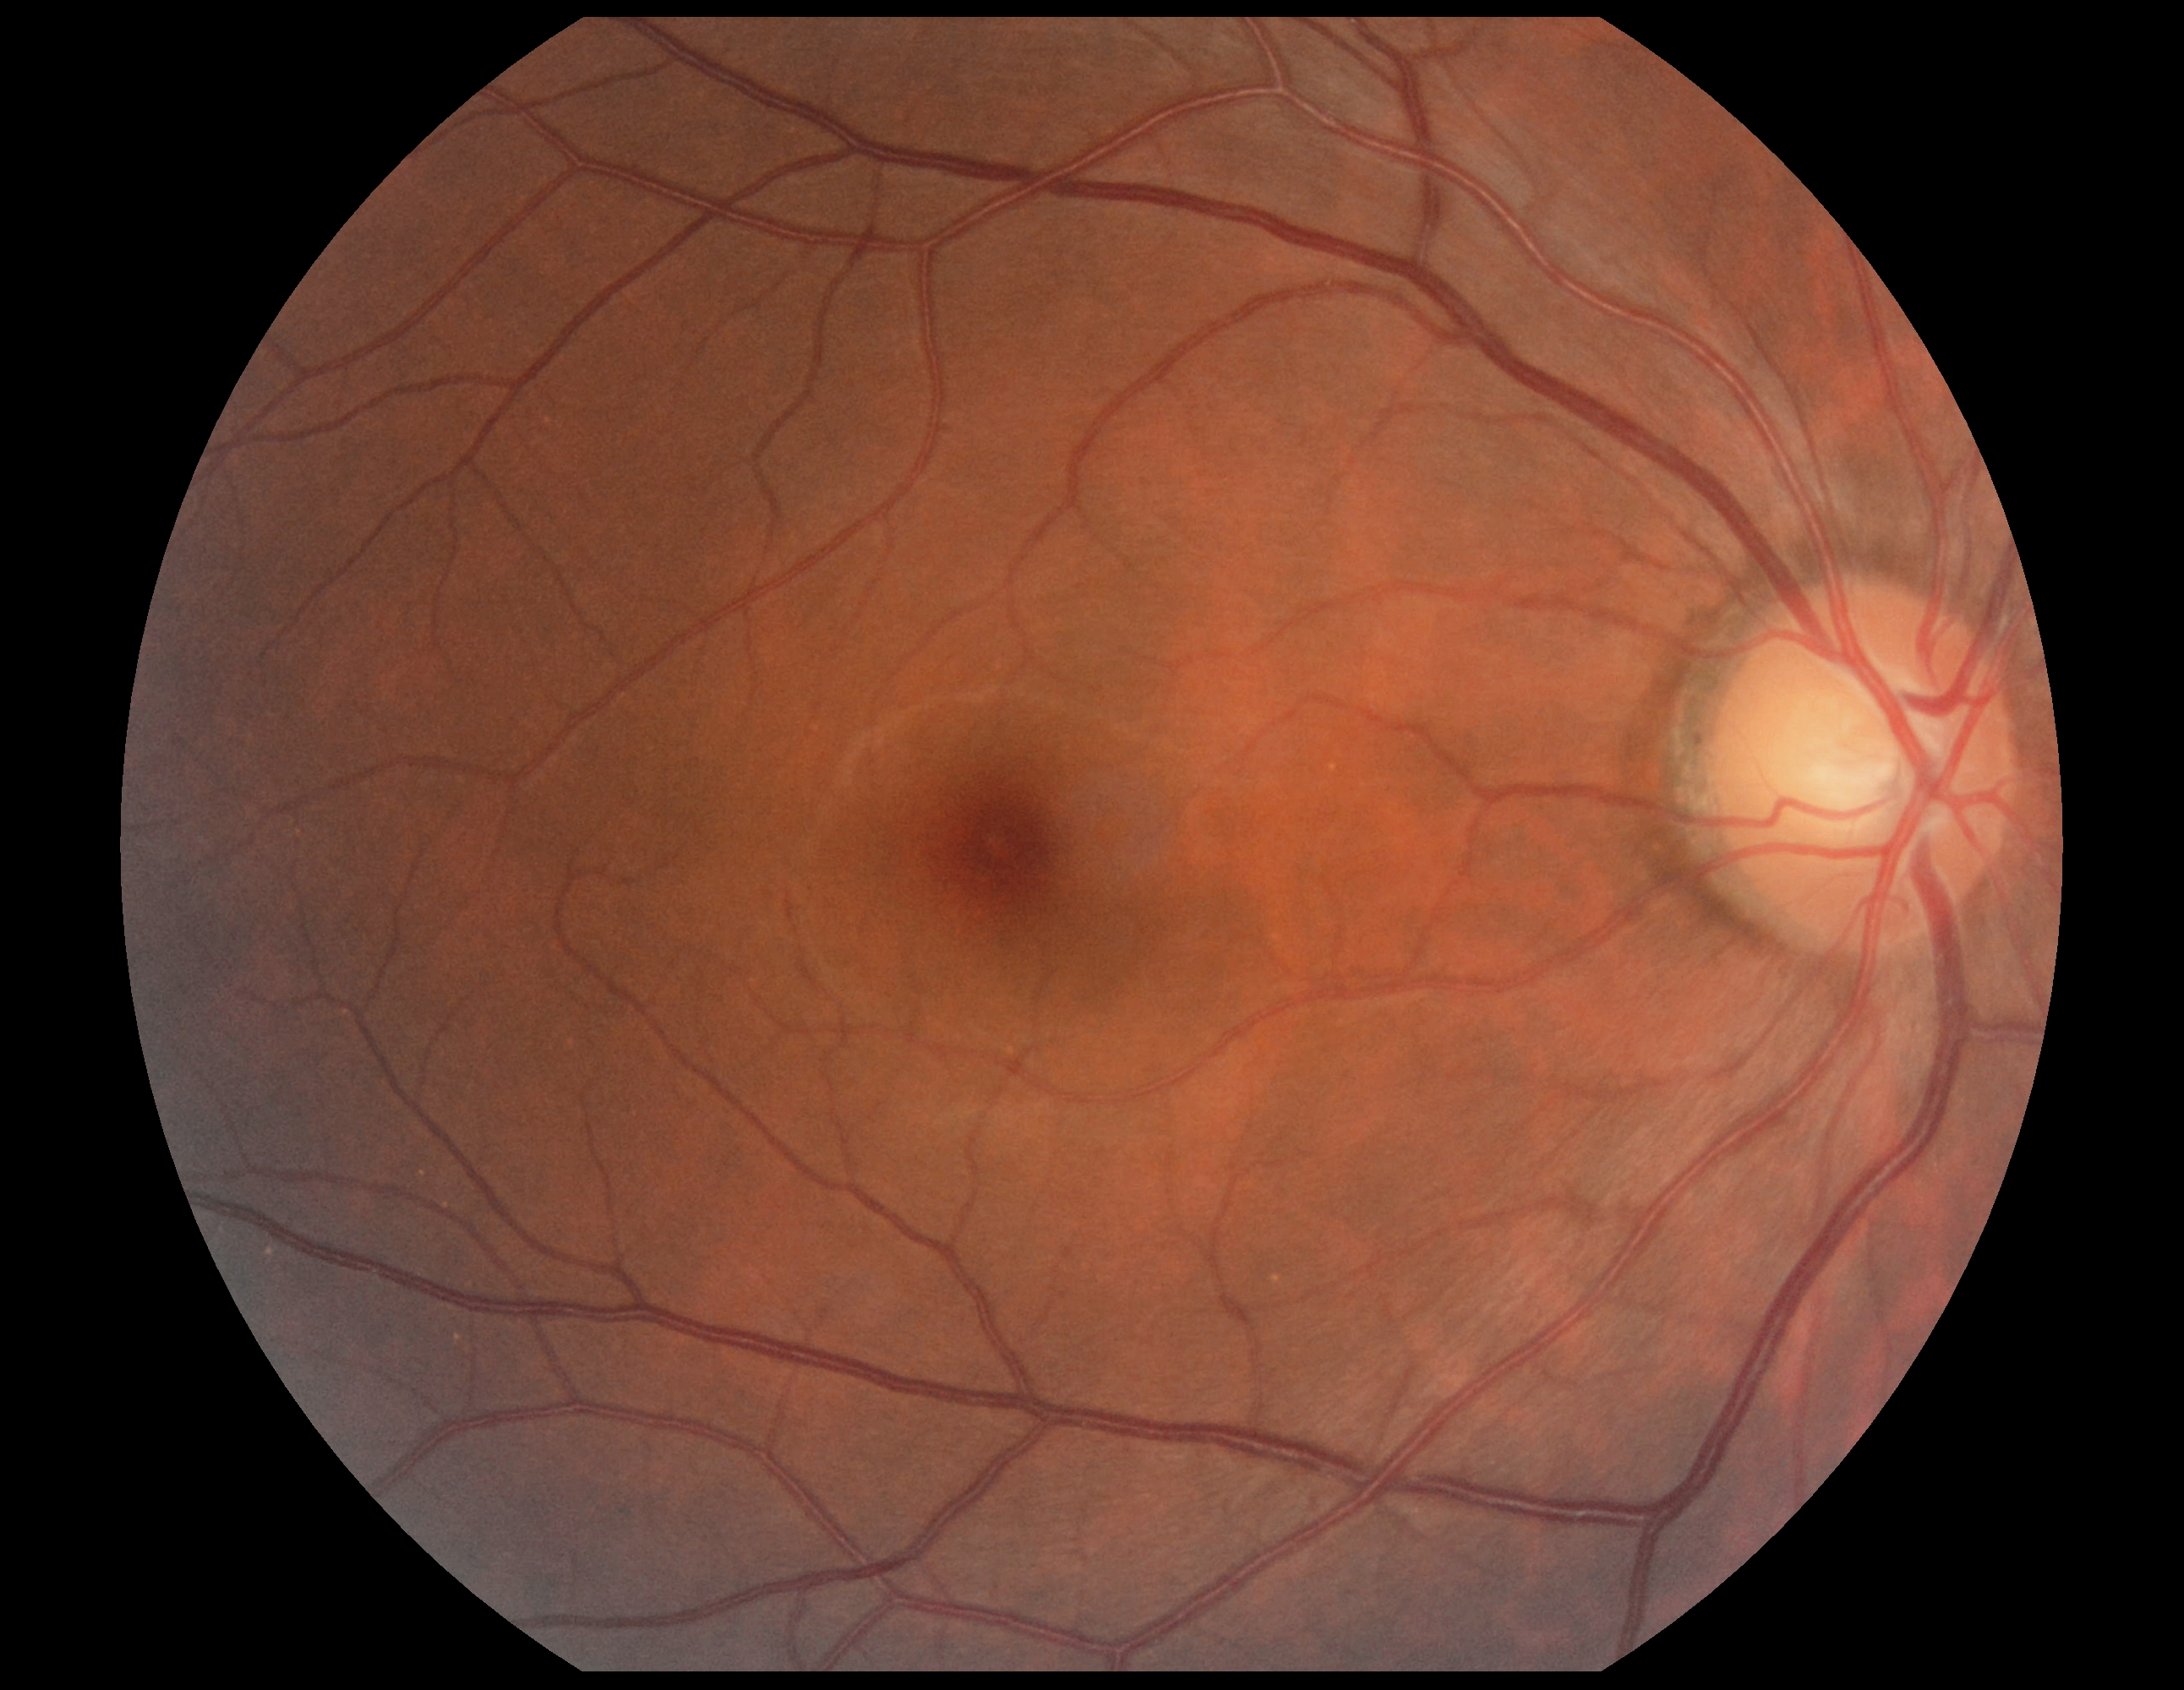

DR grade is 0 (no apparent retinopathy) — no visible signs of diabetic retinopathy.